Infant wide-field fundus photograph · 1240x1240 — 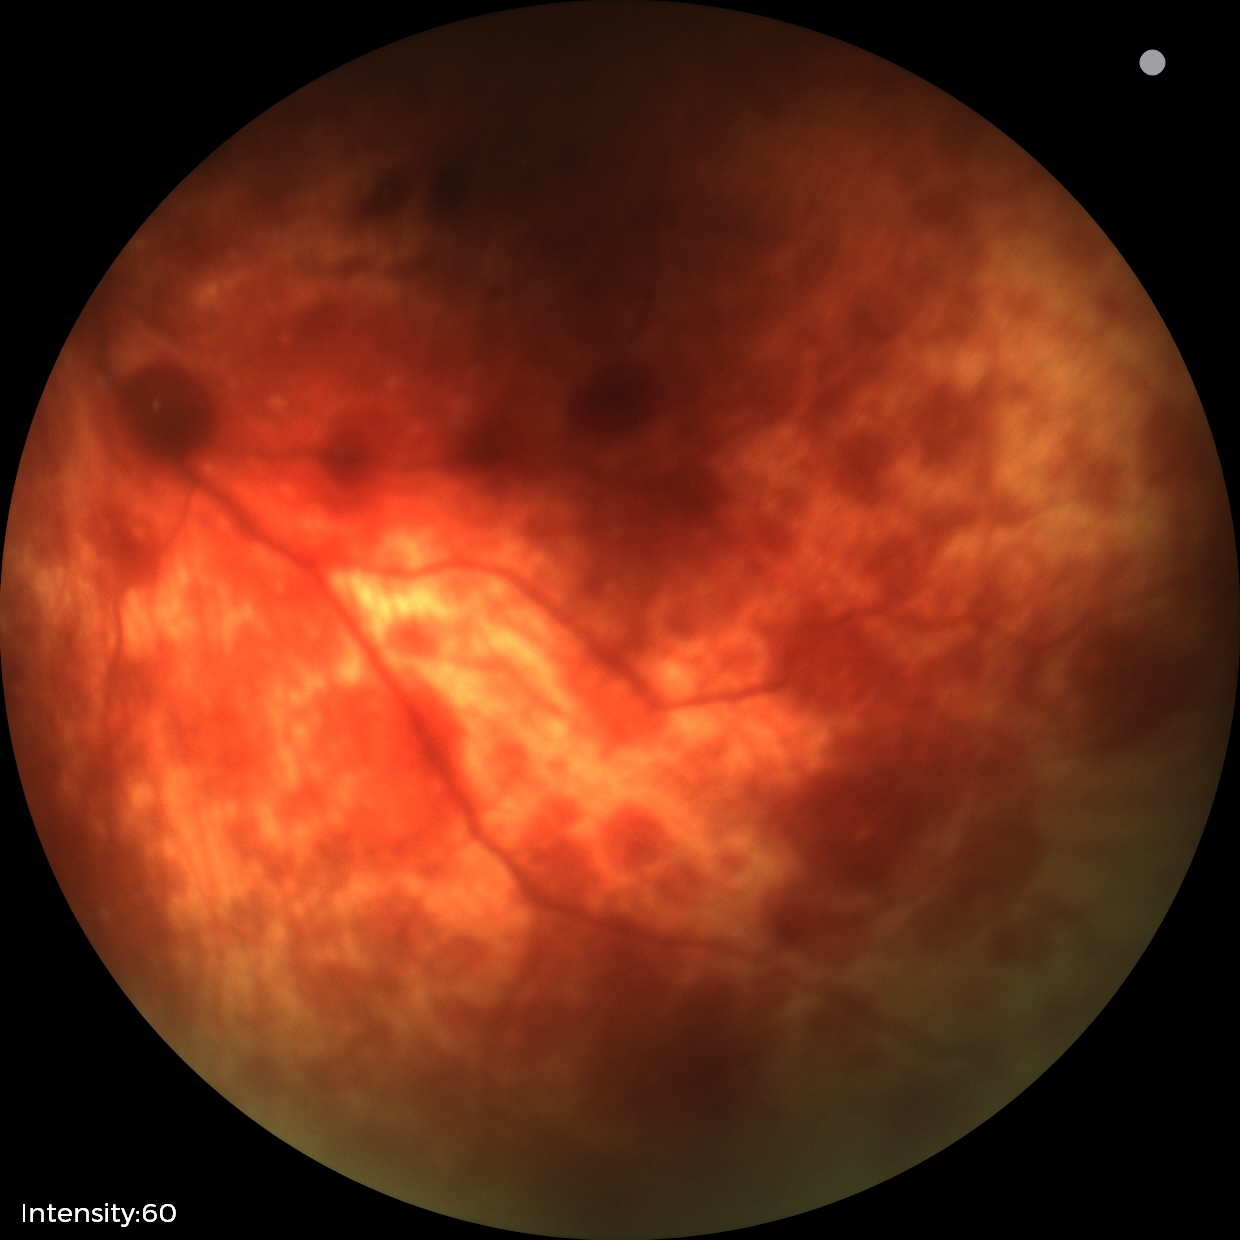
Diagnosis from this screening exam: retinal hemorrhages.